Image size 2228x1652: 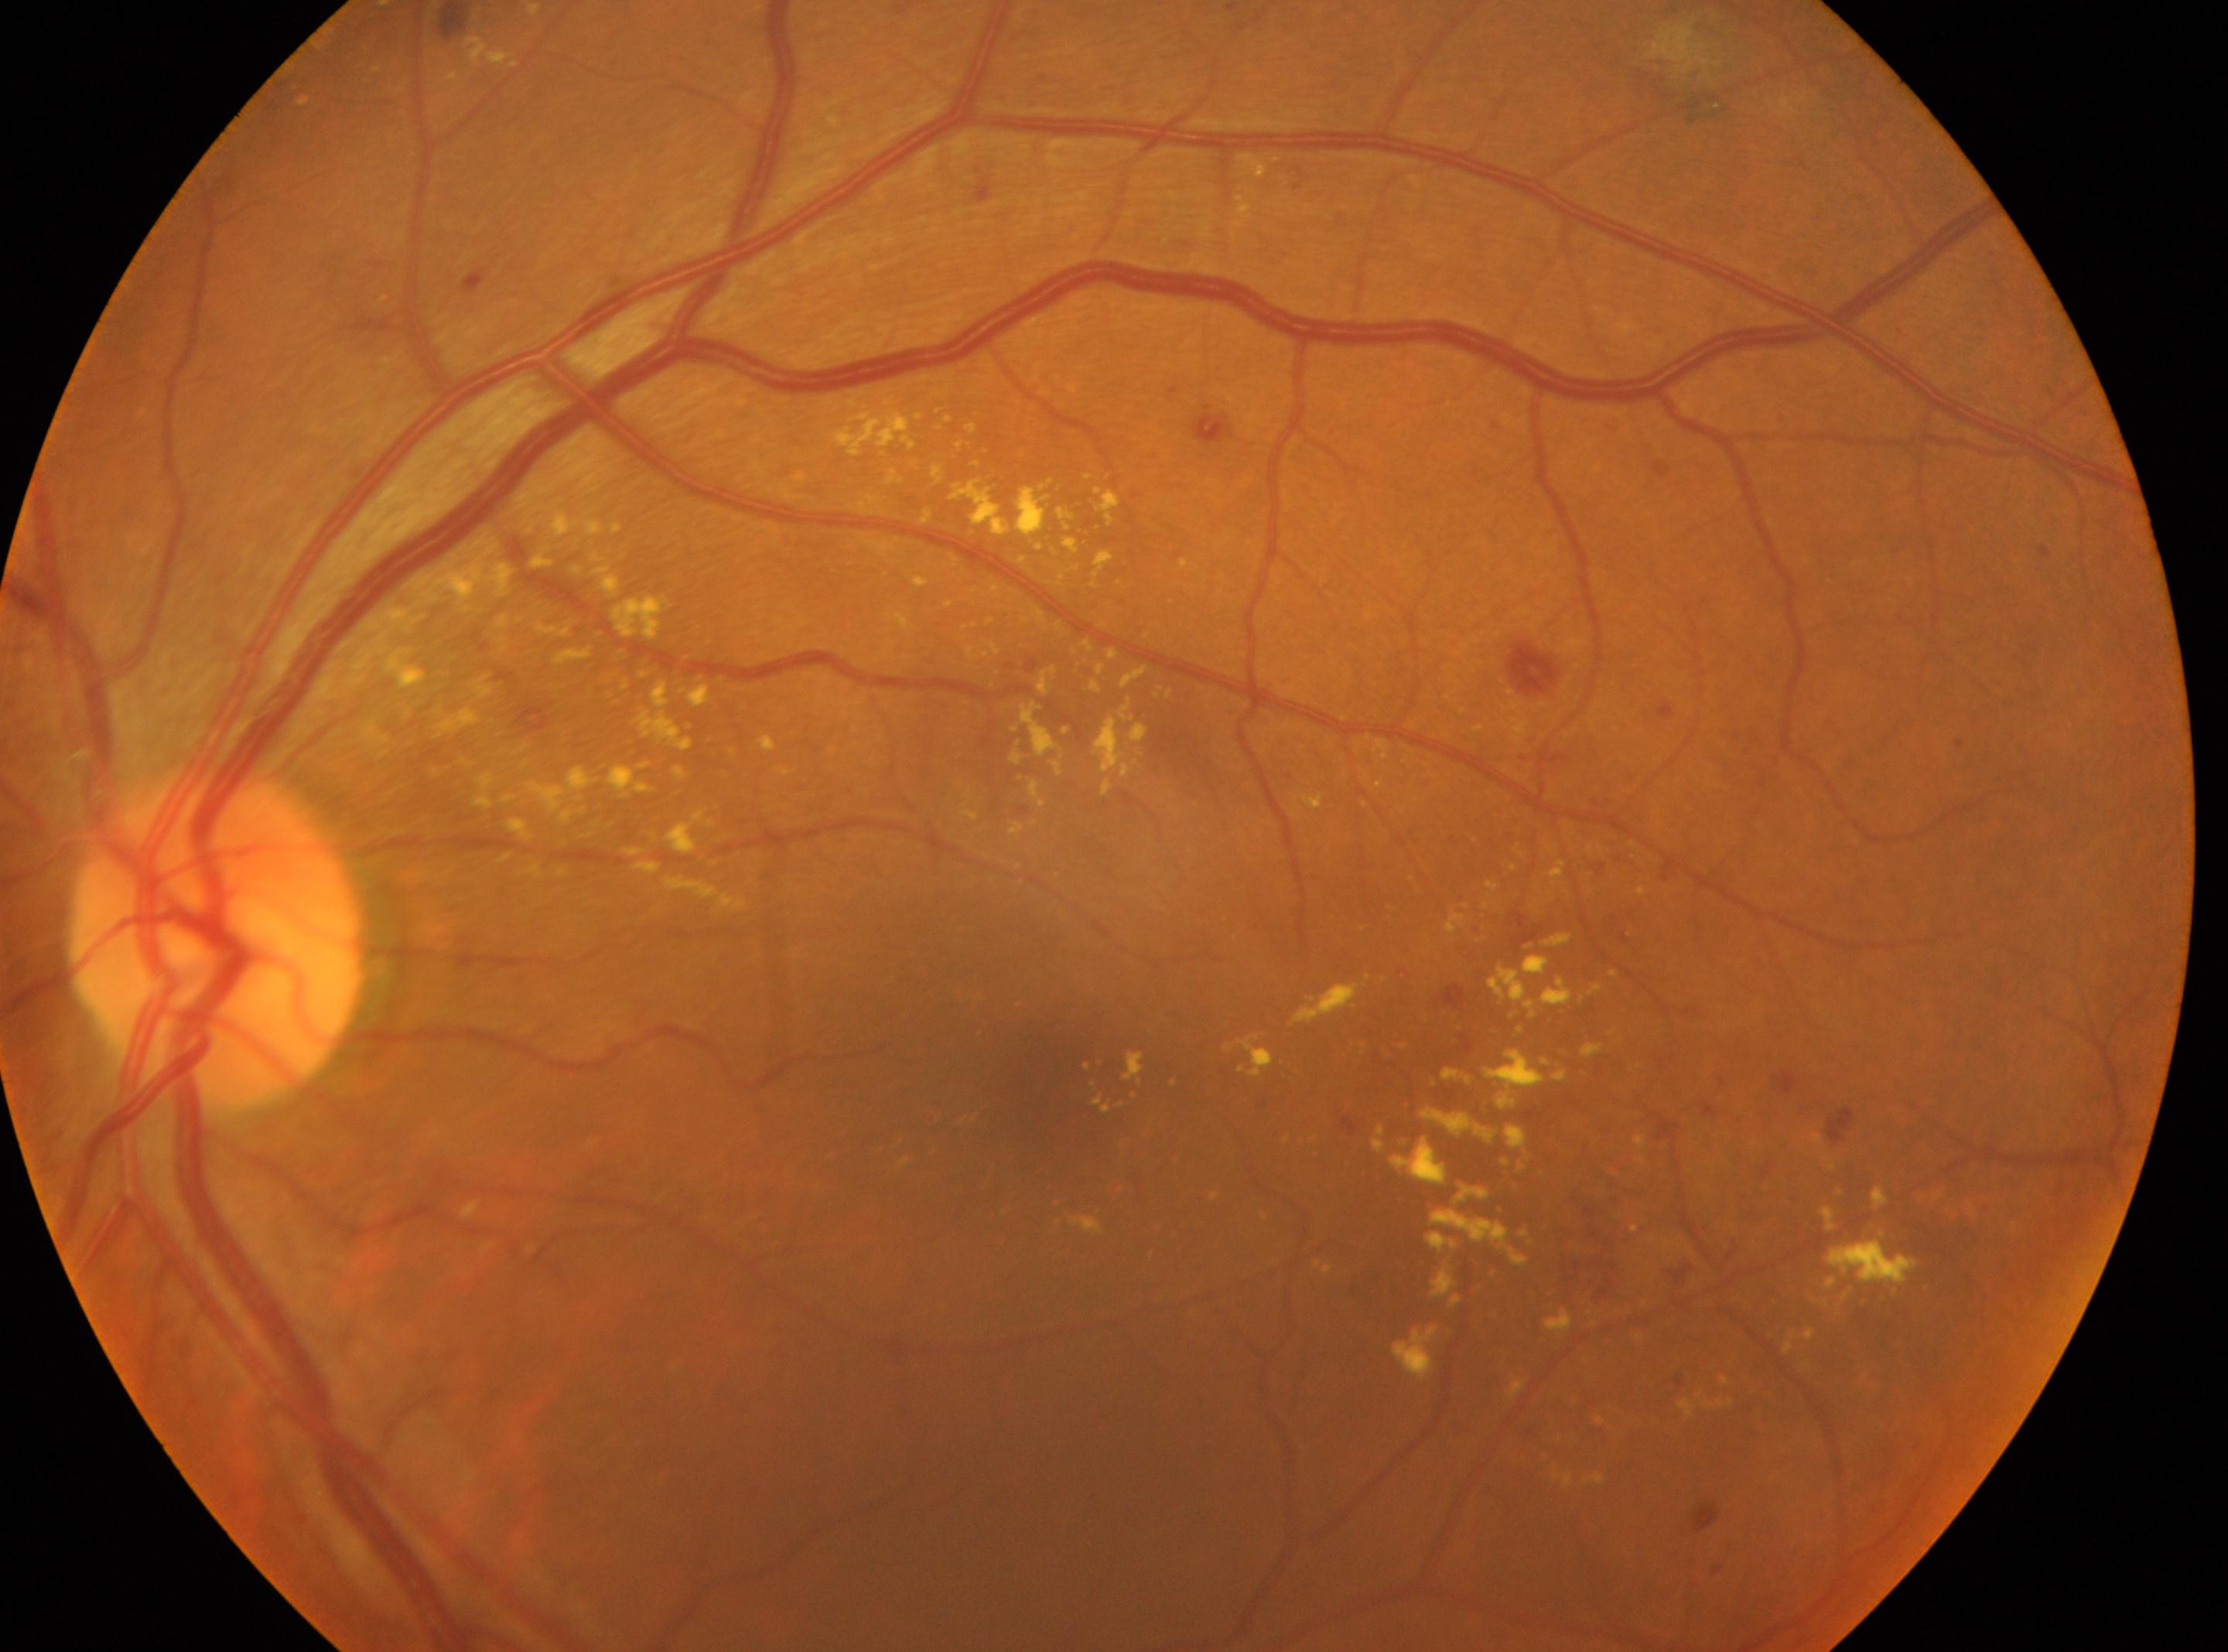 diabetic retinopathy@grade 2 — more than just microaneurysms but less than severe NPDR; disc center@(x: 218, y: 940); macula center@(x: 1027, y: 1073); non-proliferative diabetic retinopathy; left.